Remidio FOP fundus camera; CFP
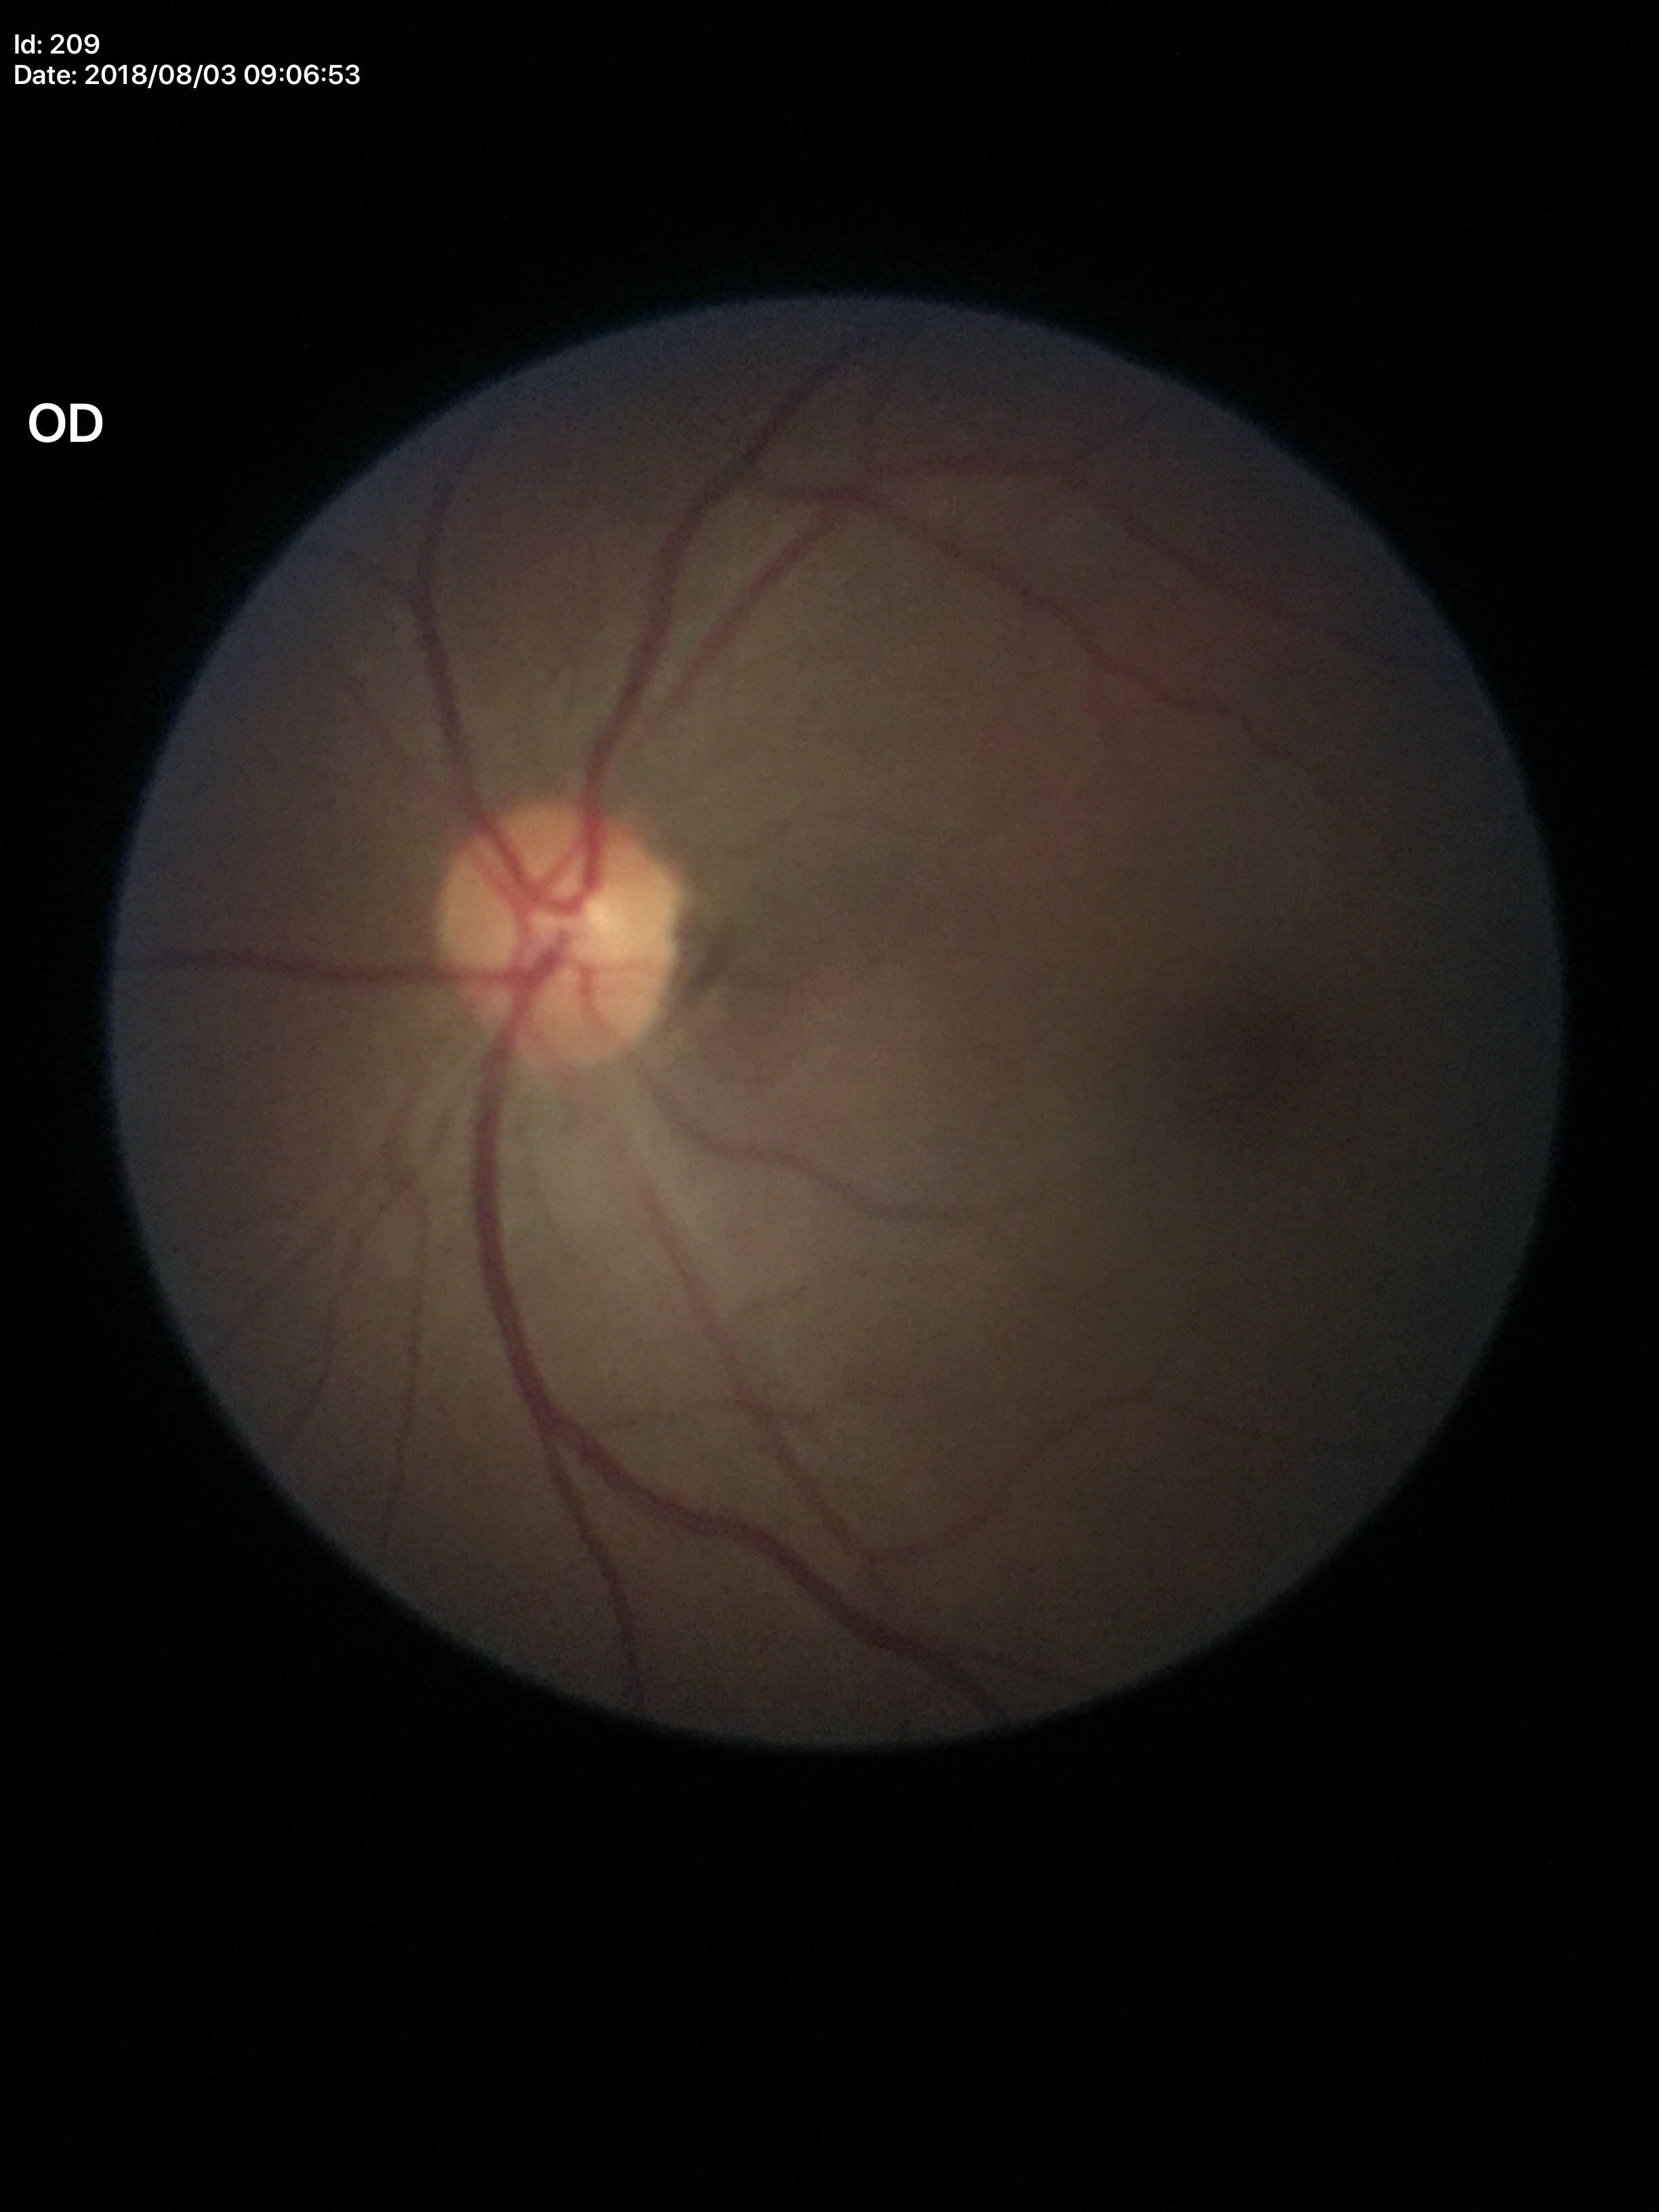 Optic disc analysis:
• Glaucoma decision — not suspect
• vertical C/D ratio (VCDR) — 0.33
• horizontal C/D ratio (HCDR) — 0.40